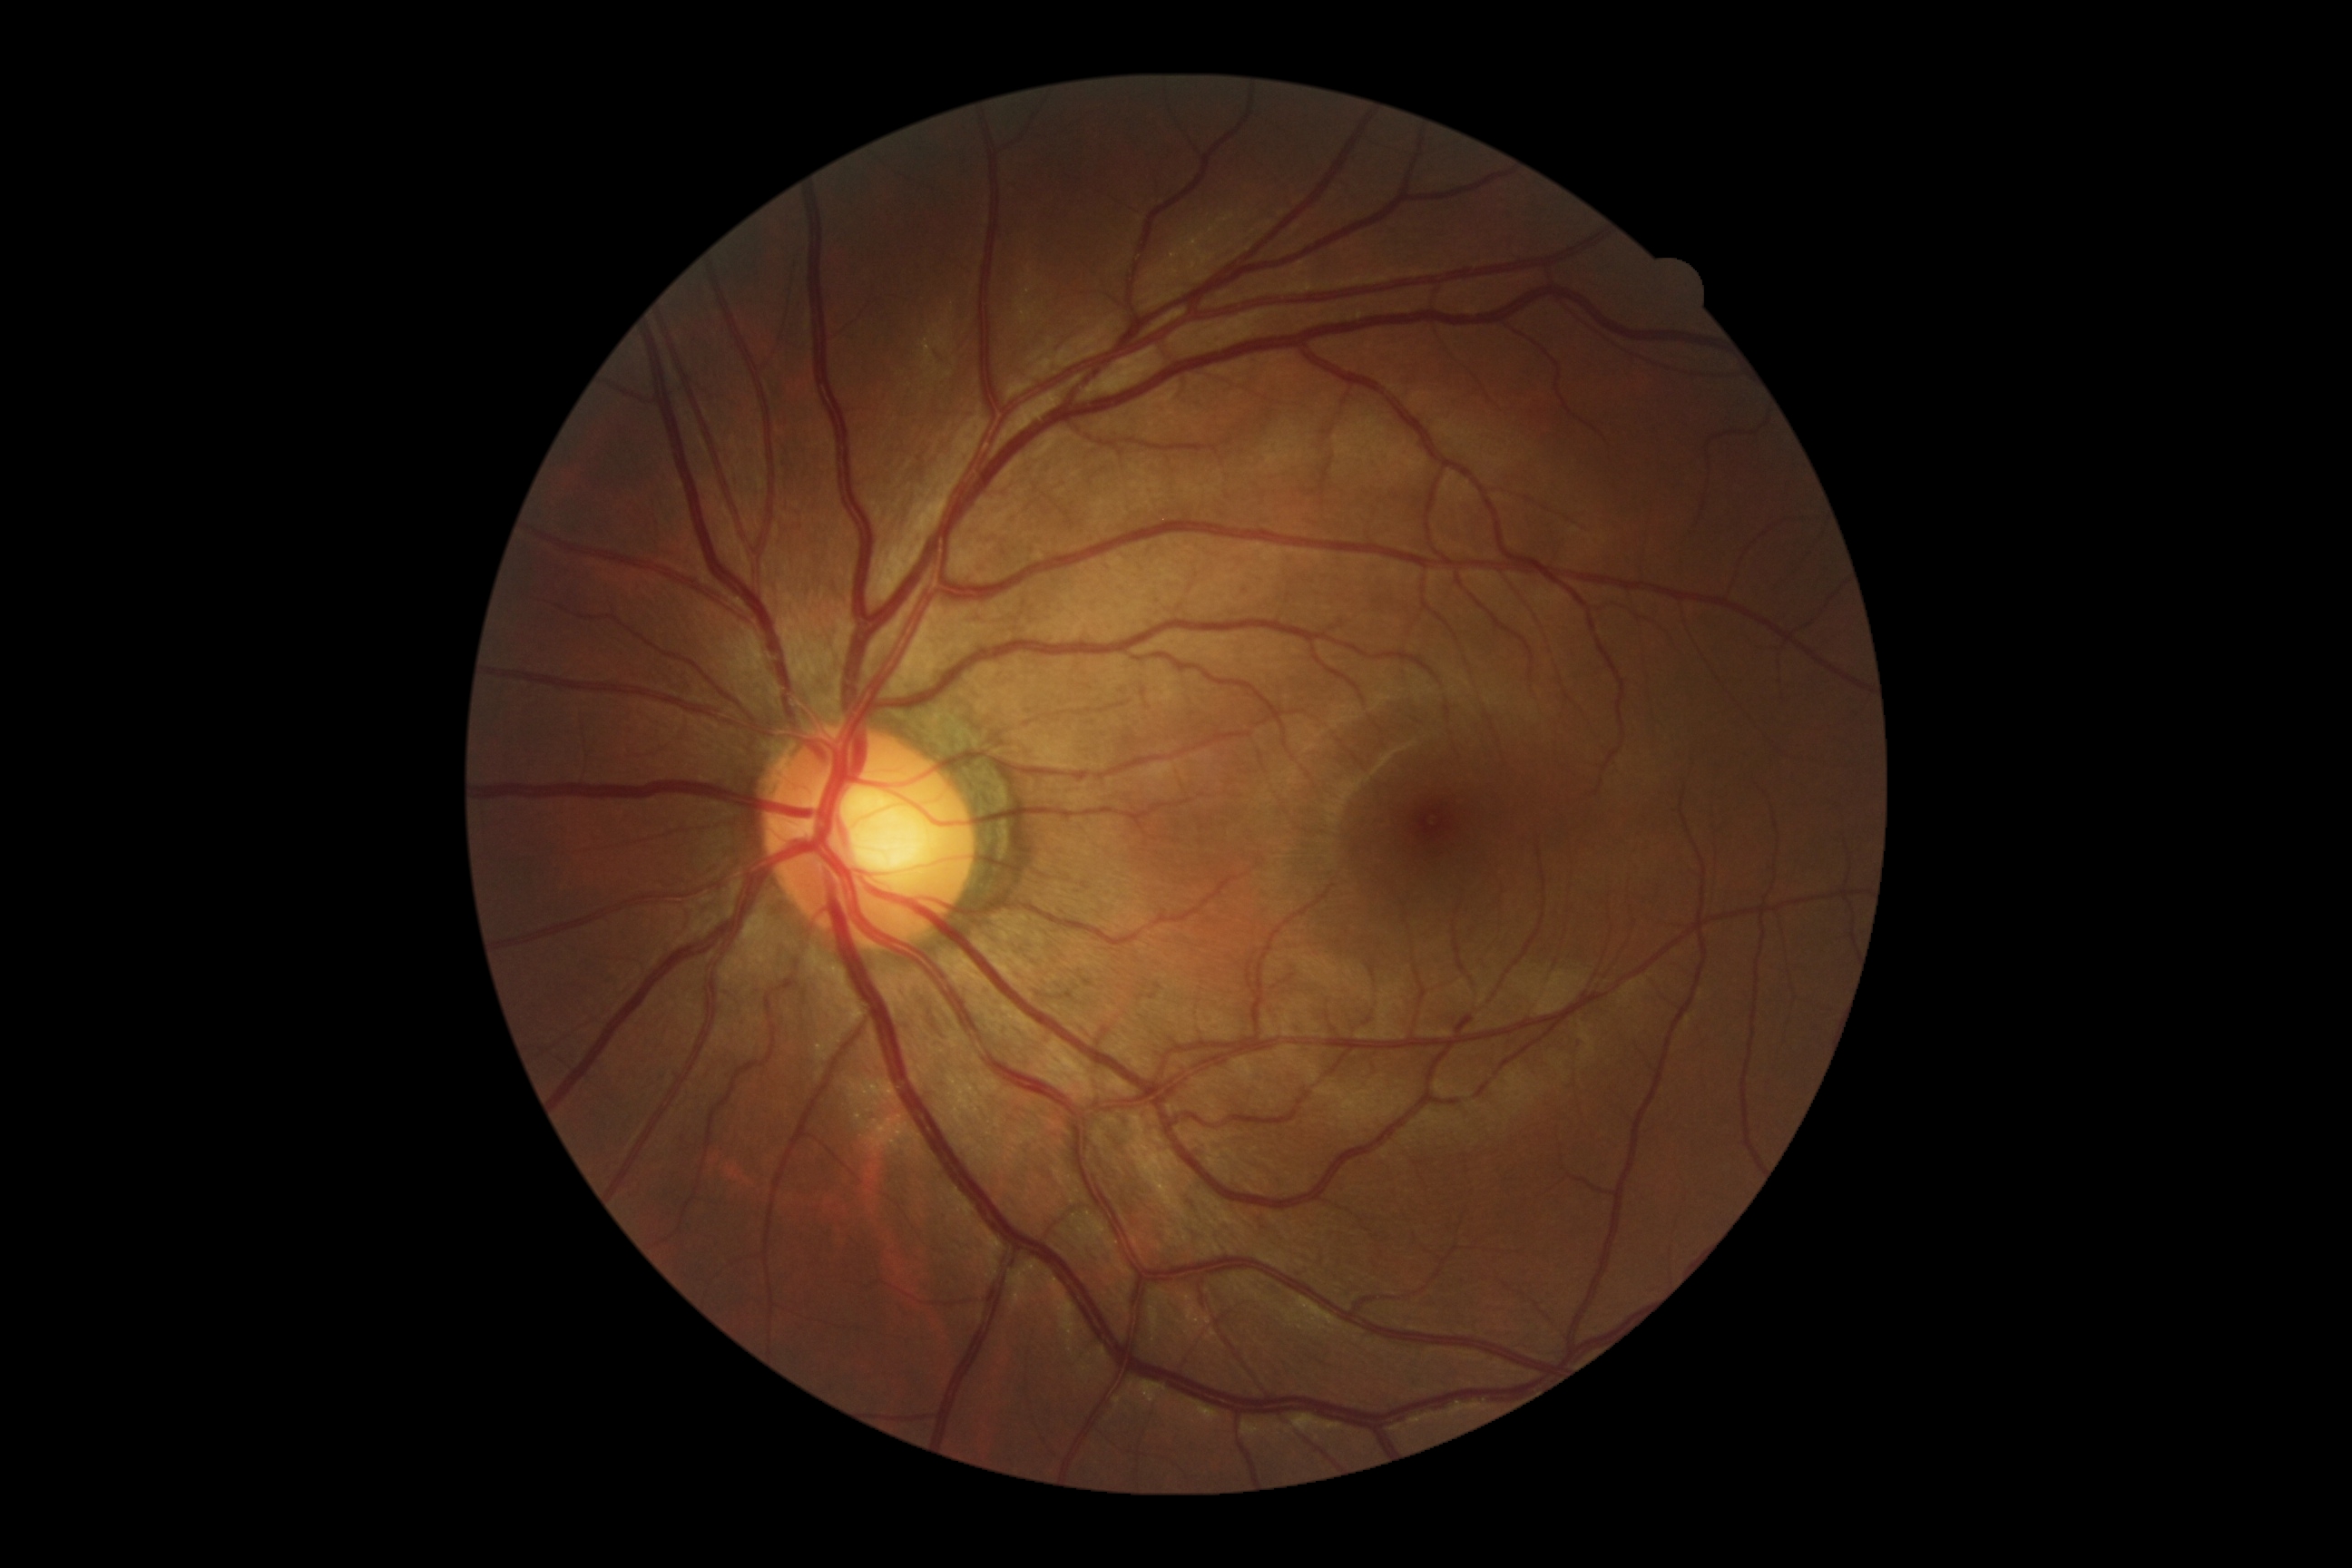 DR severity: no apparent retinopathy (grade 0).